45° field of view; posterior pole color fundus photograph
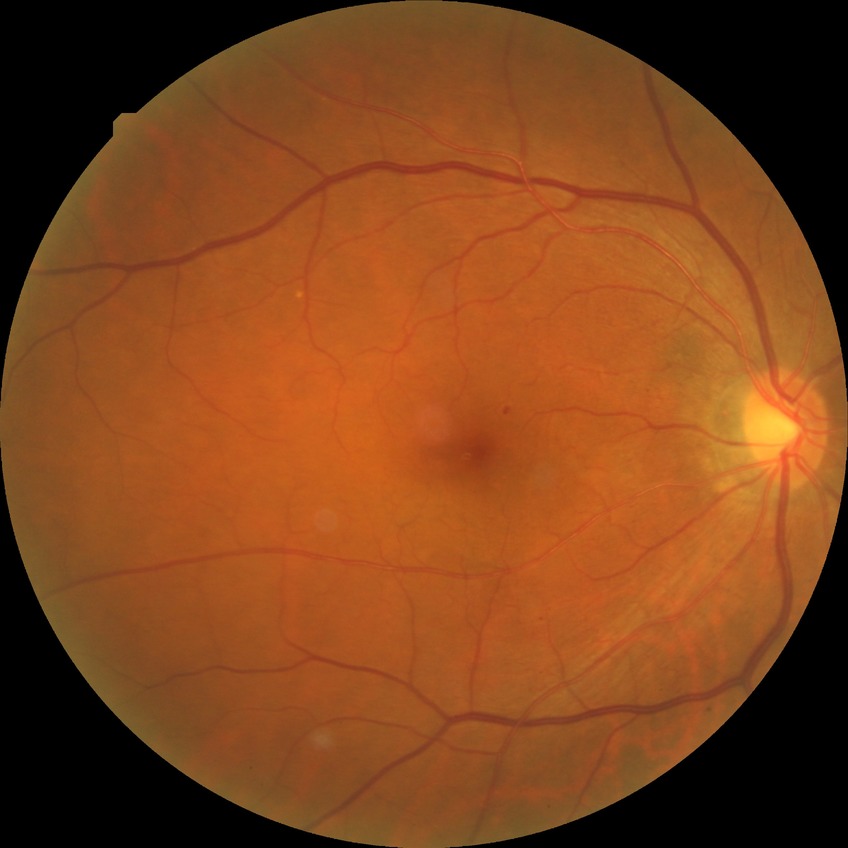 {"davis_grade": "SDR"}